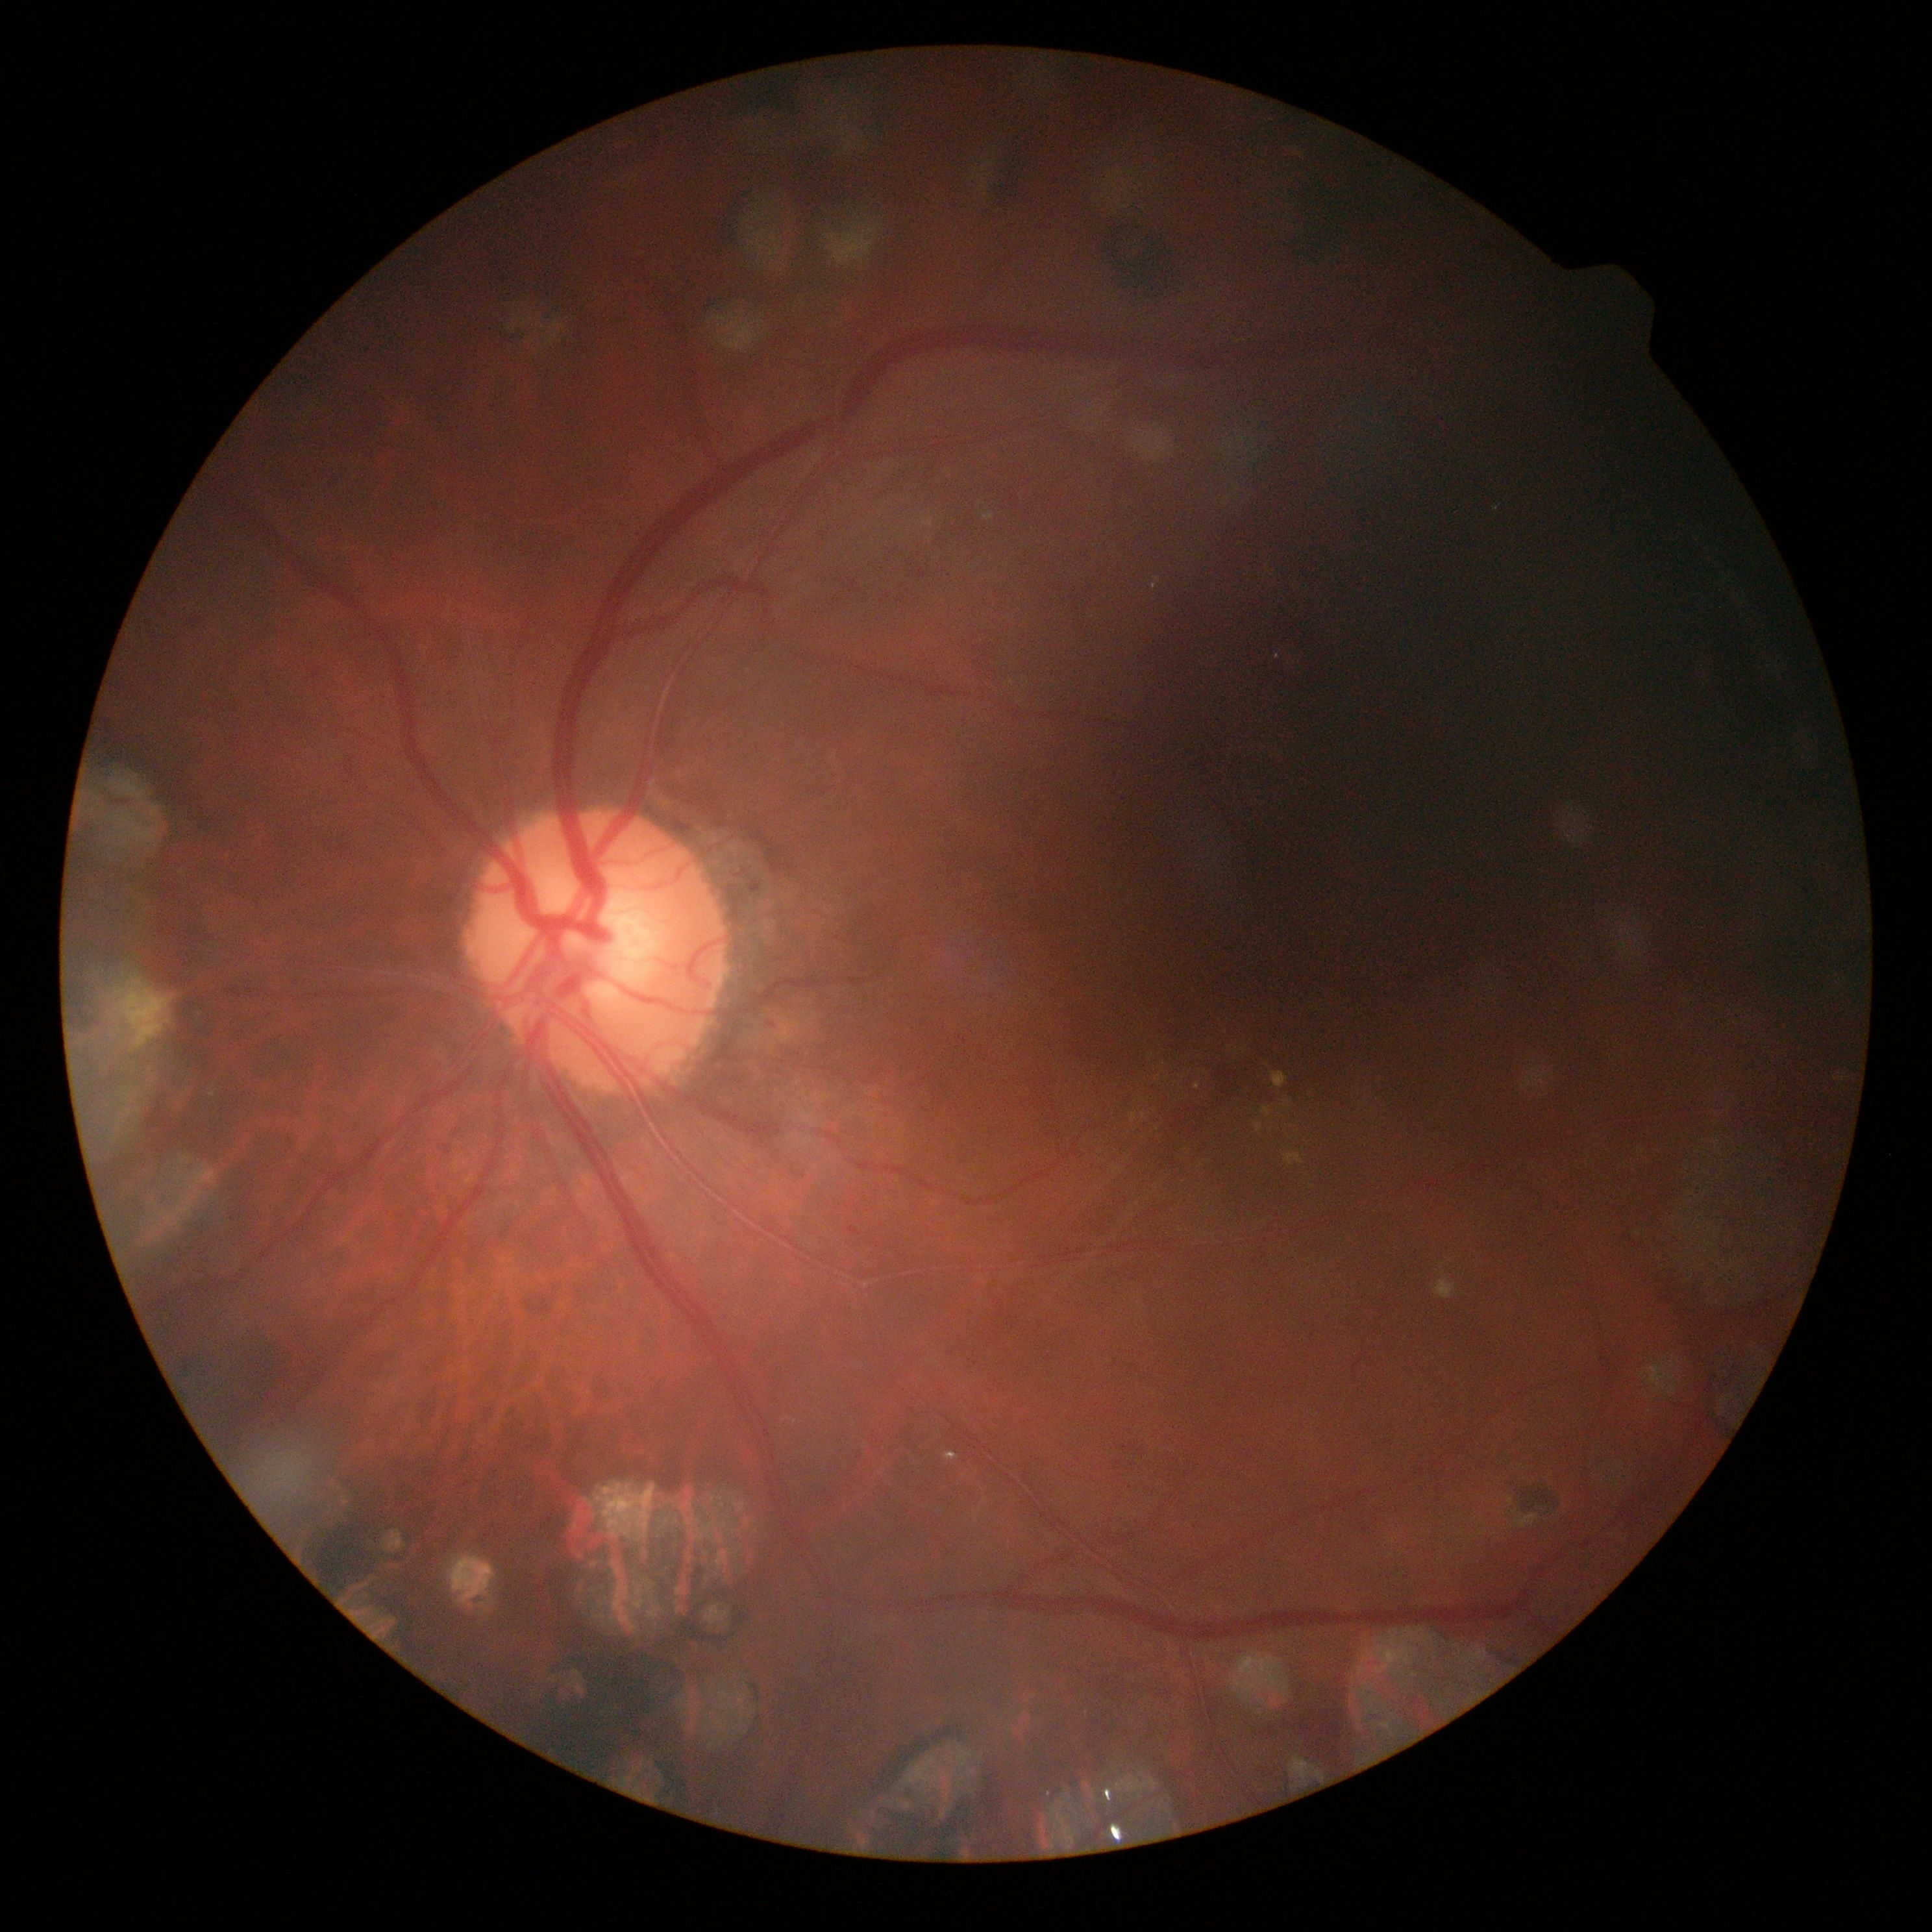

Diabetic retinopathy (DR) is 2/4.